Davis DR grading.
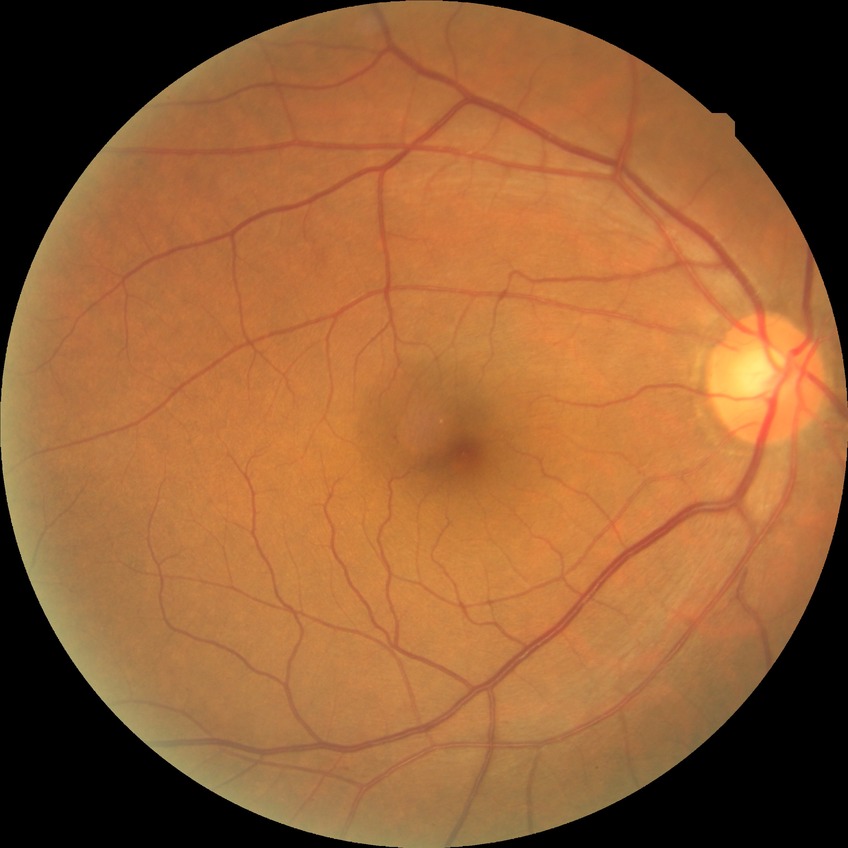
Modified Davis grading: no diabetic retinopathy.